Color fundus image: 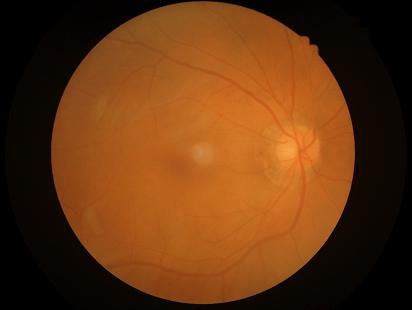

  contrast: low
  clarity: blurry
  illumination: good
  overall_quality: poor